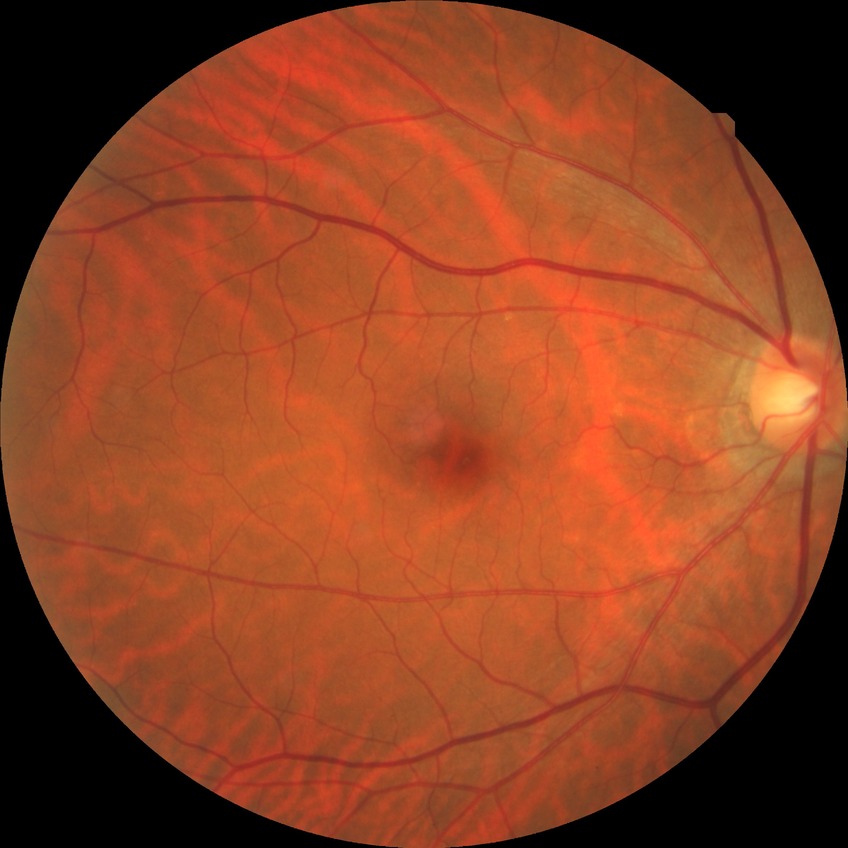
Assessment:
* diabetic retinopathy (DR): no diabetic retinopathy (NDR)